Fundus photo:
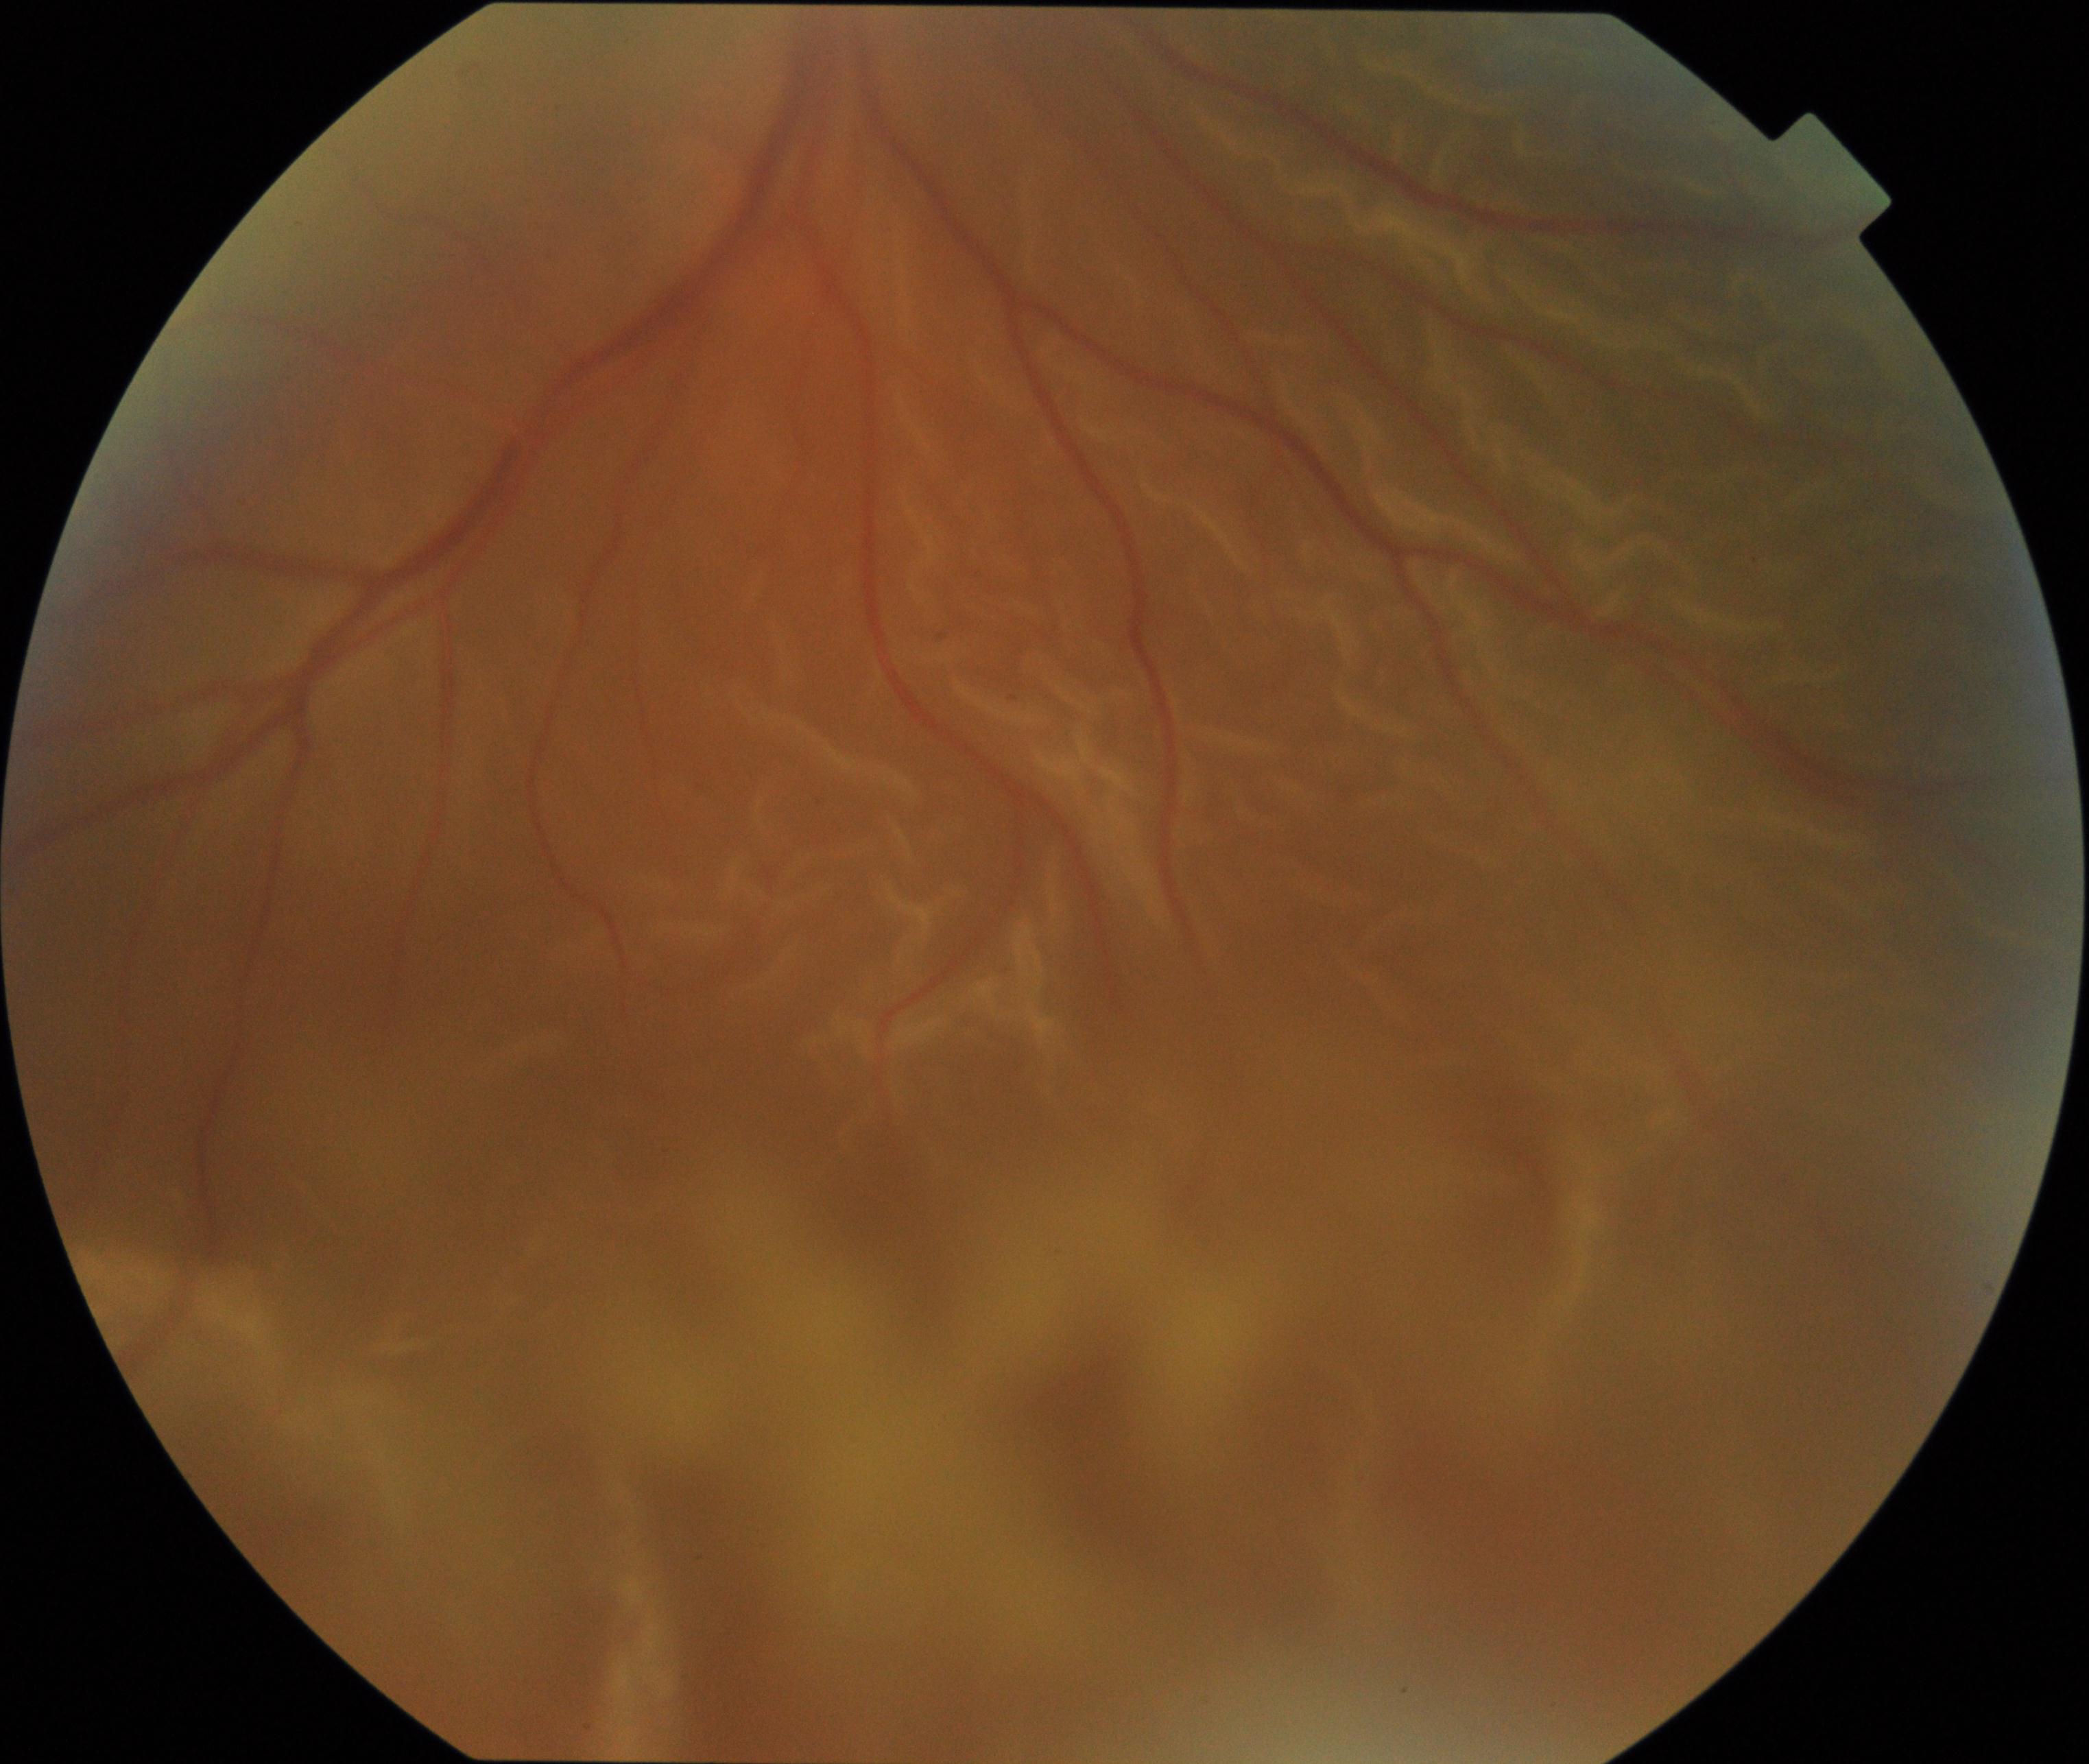
Impression: rhegmatogenous retinal detachment.